Wide-field fundus image from infant ROP screening: 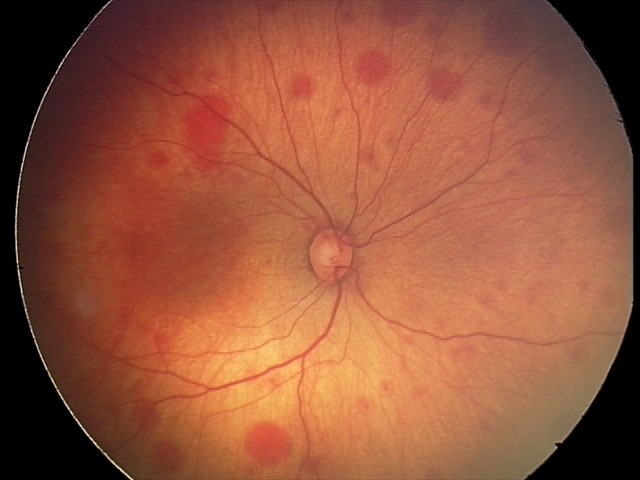
Series diagnosed as retinal hemorrhages.